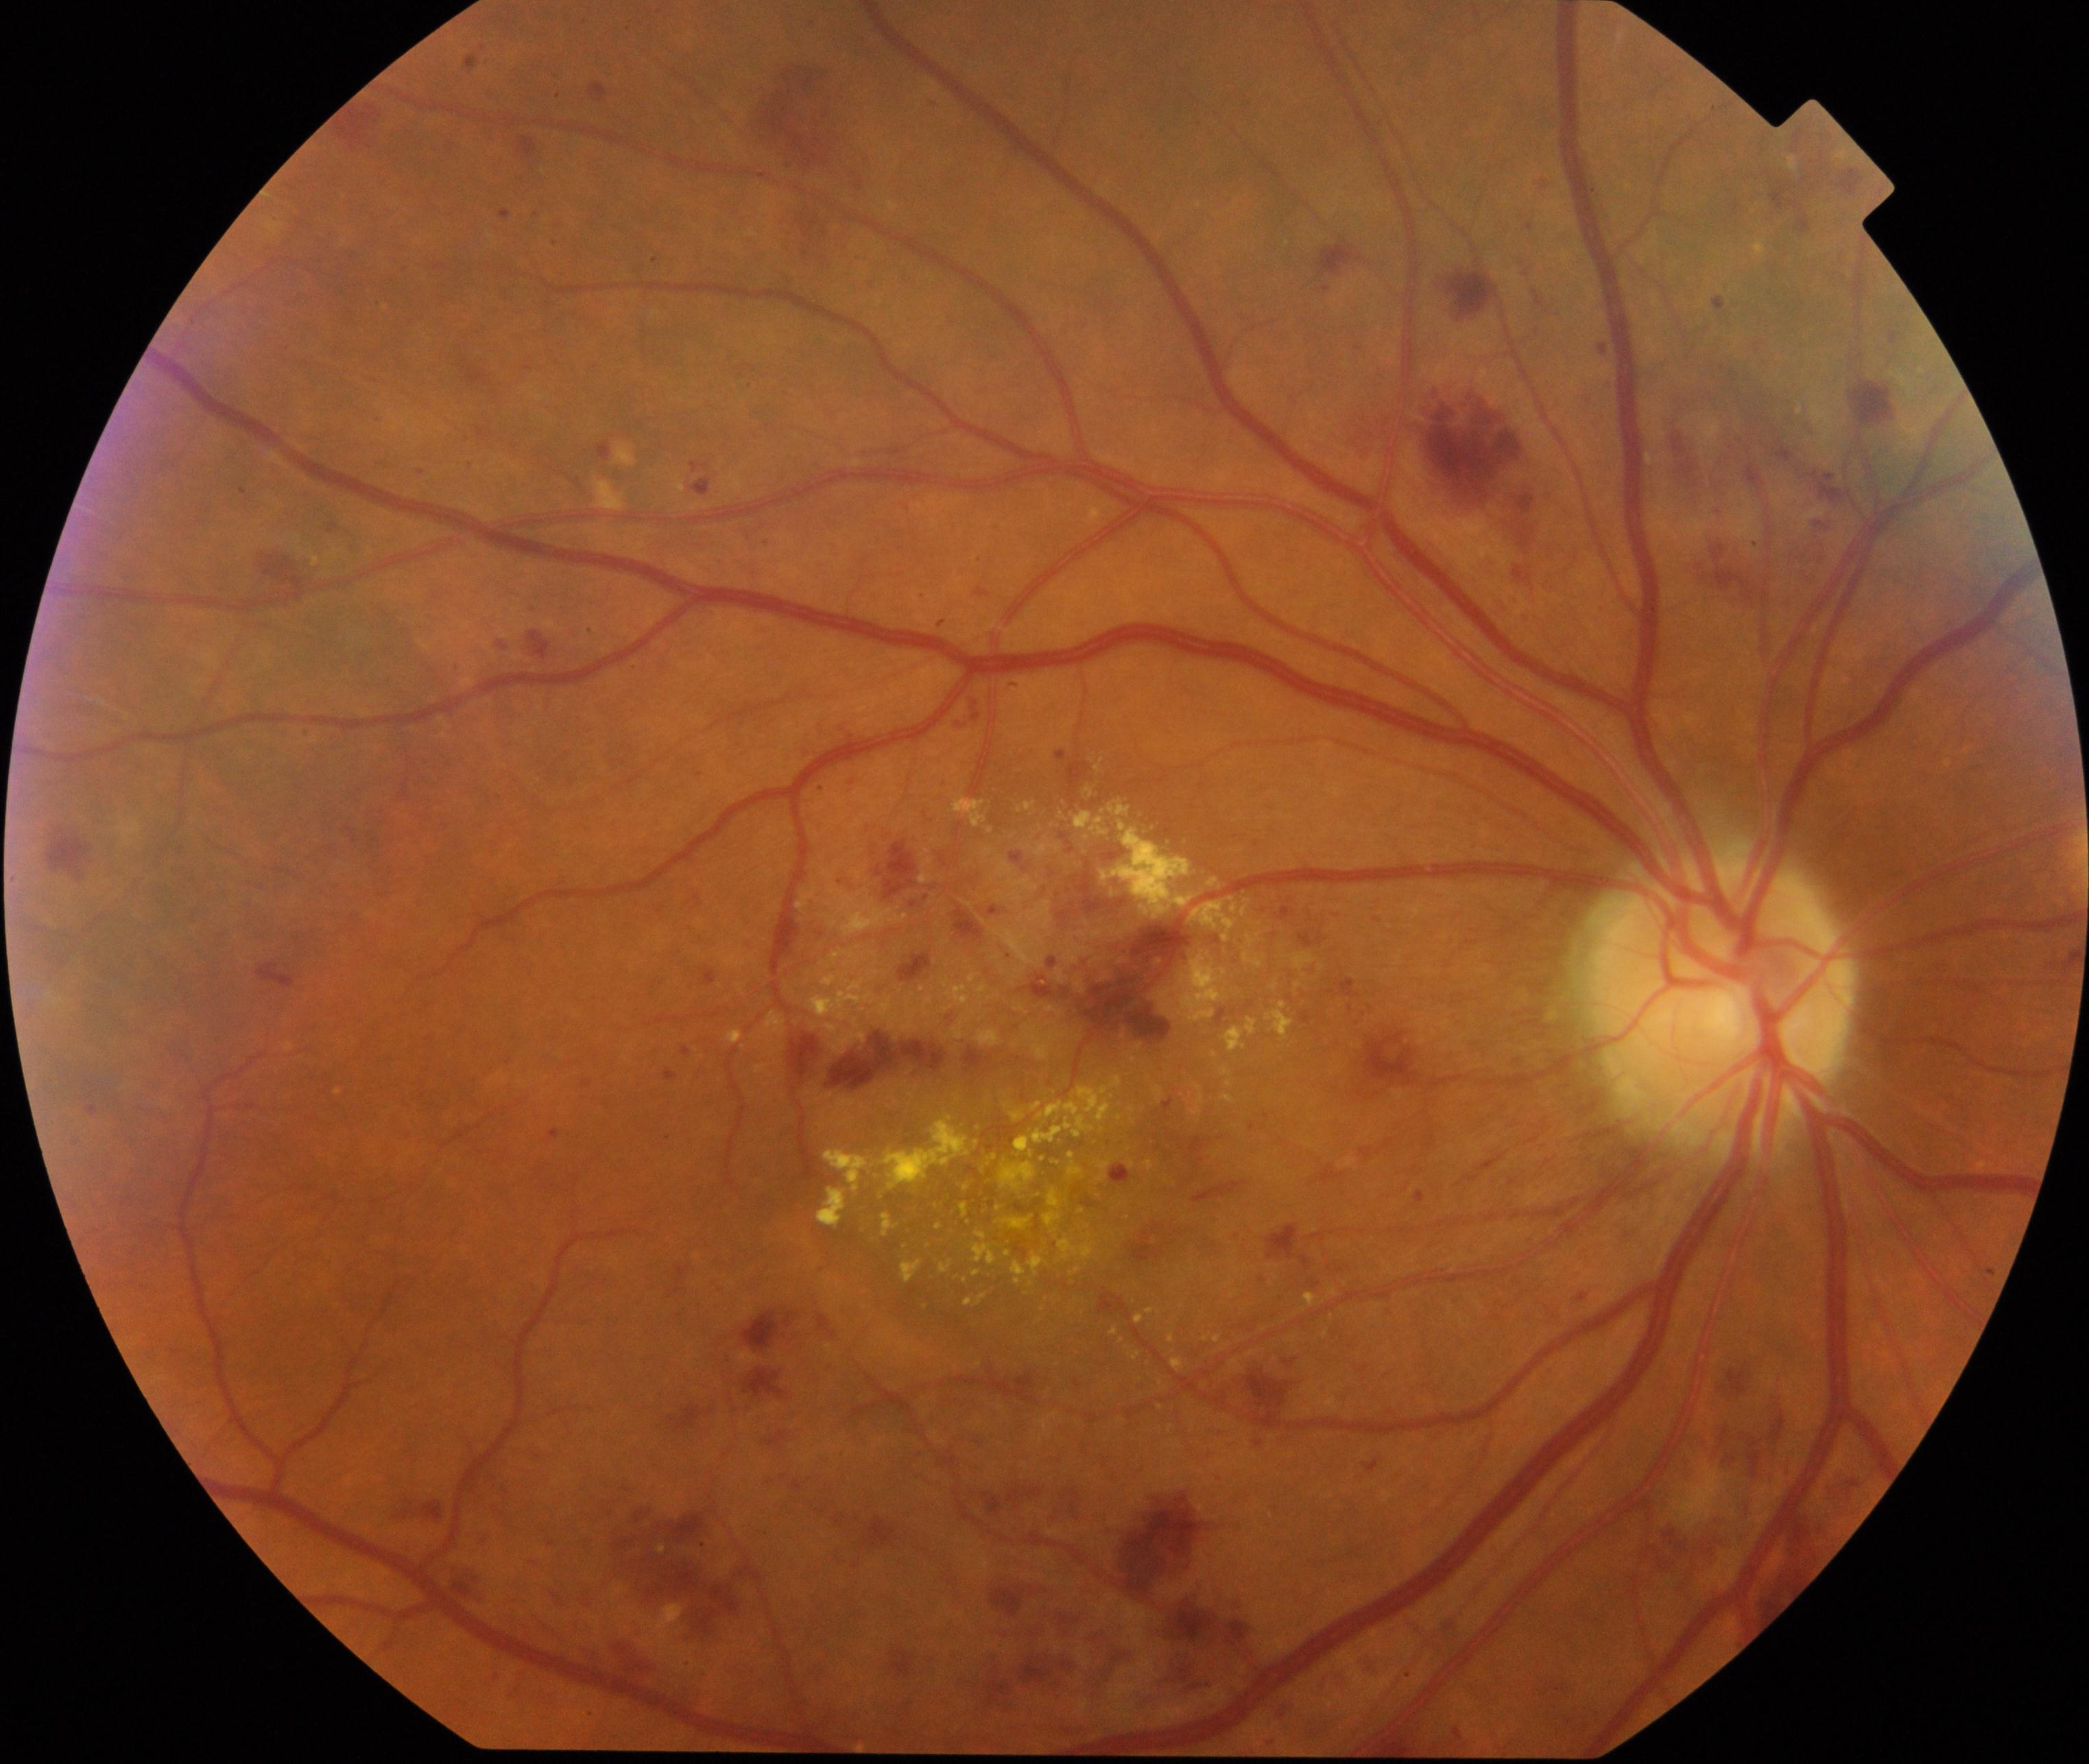 Color fundus photograph showing moderate non-proliferative diabetic retinopathy. Typically showing microaneurysms with dot and blot hemorrhages or hard exudates, less than severe non-proliferative diabetic retinopathy, and/or with diabetic macular edema.